848 x 848 pixels. 45° field of view. Nonmydriatic fundus photograph. CFP. Camera: NIDEK AFC-230 — 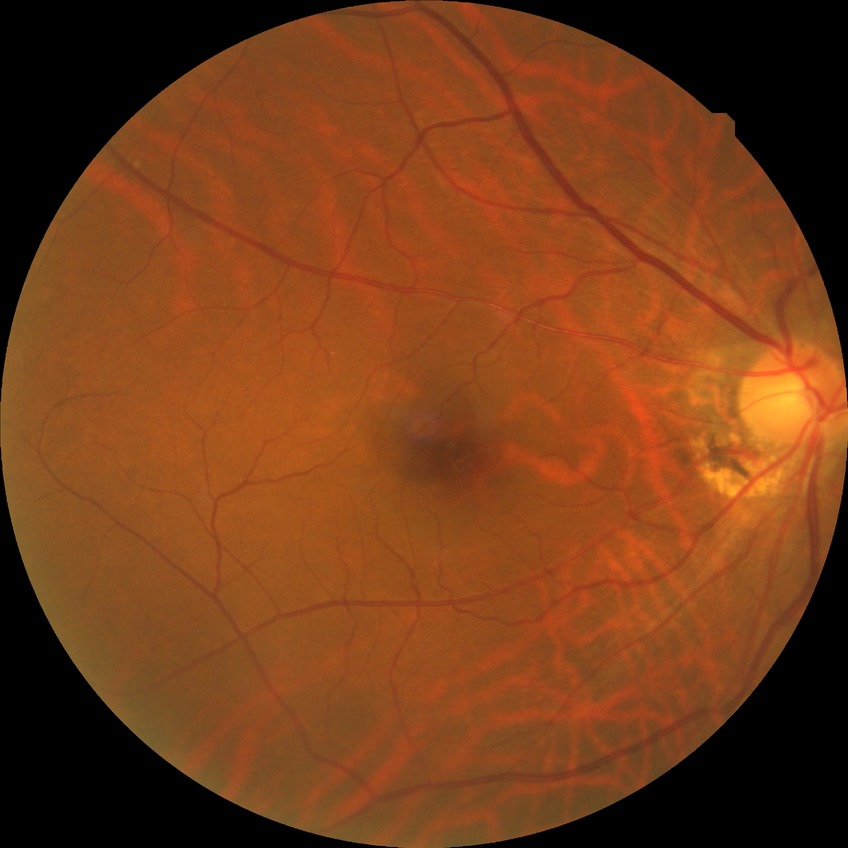

modified Davis grading = no diabetic retinopathy.